45° field of view; retinal fundus photograph; 1920 x 1088 pixels: 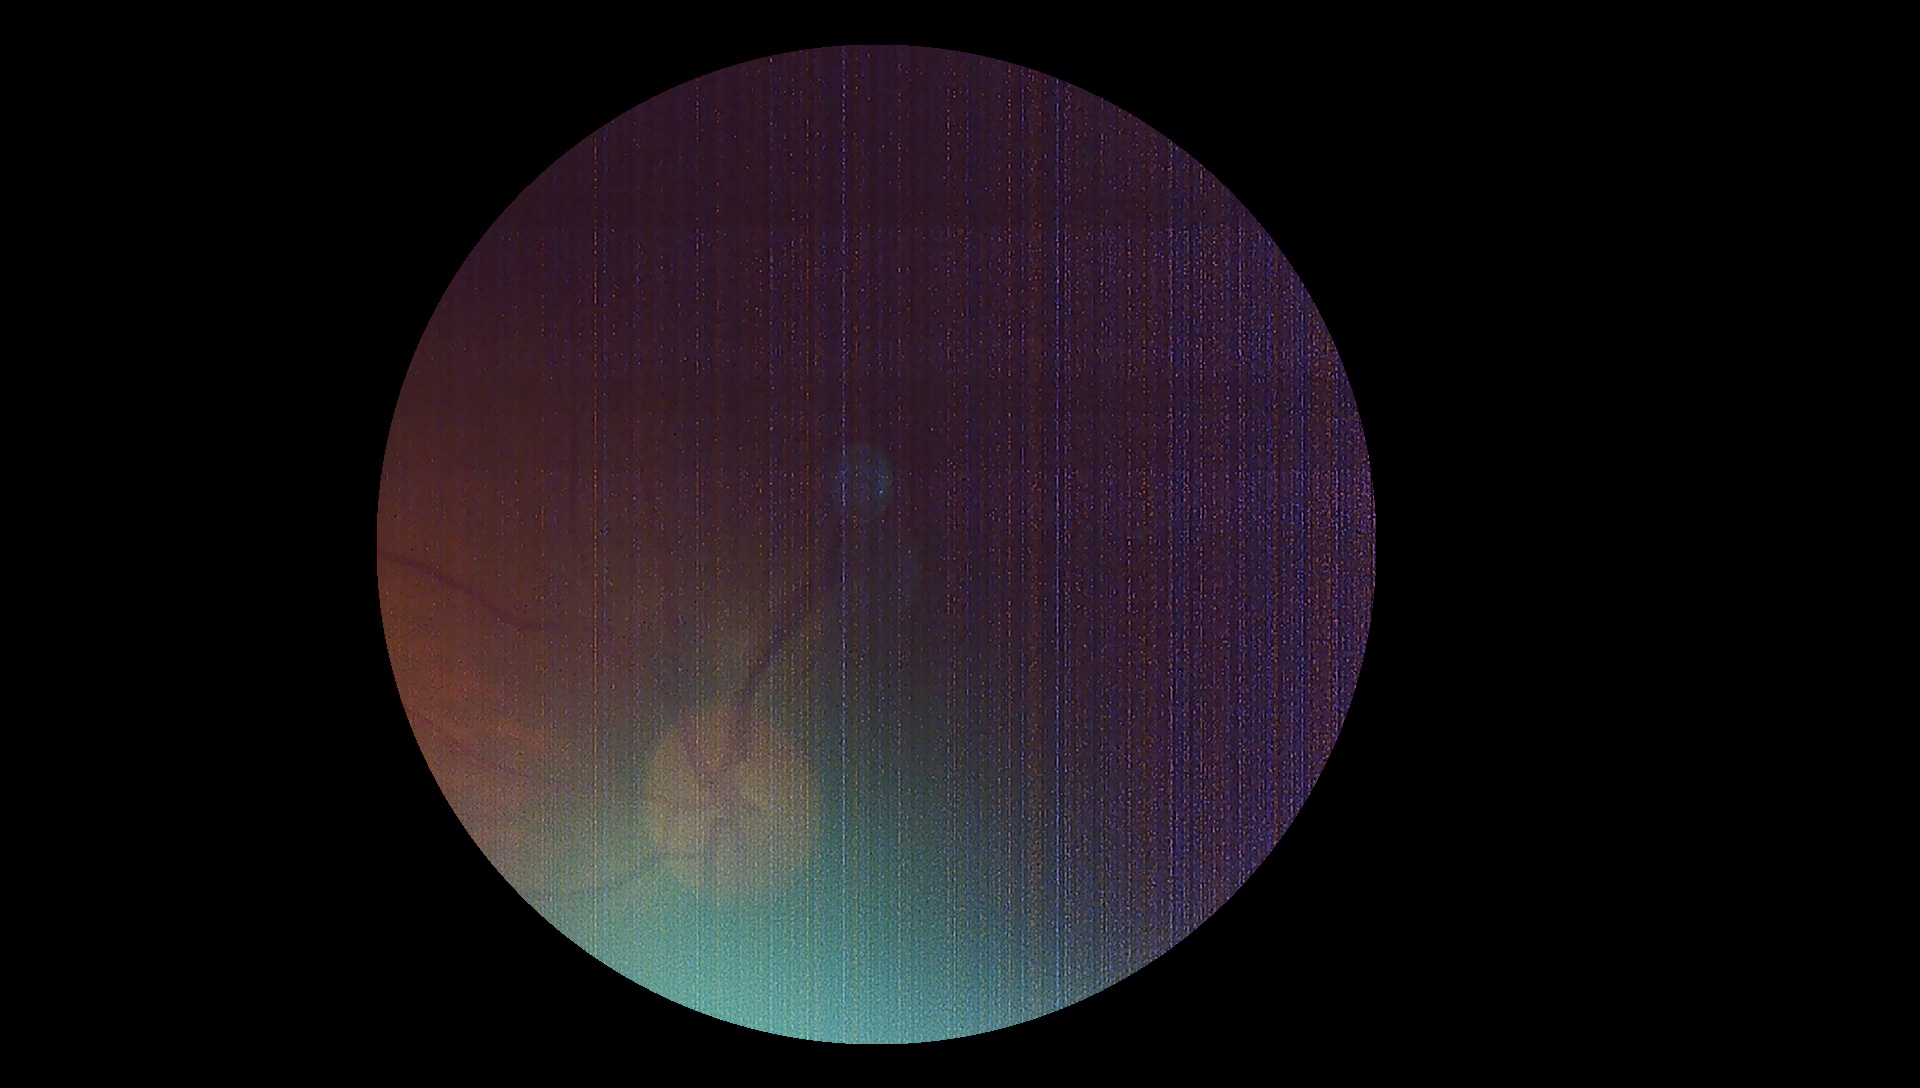

DR: ungradable due to poor image quality.
Quality too poor to assess for DR.